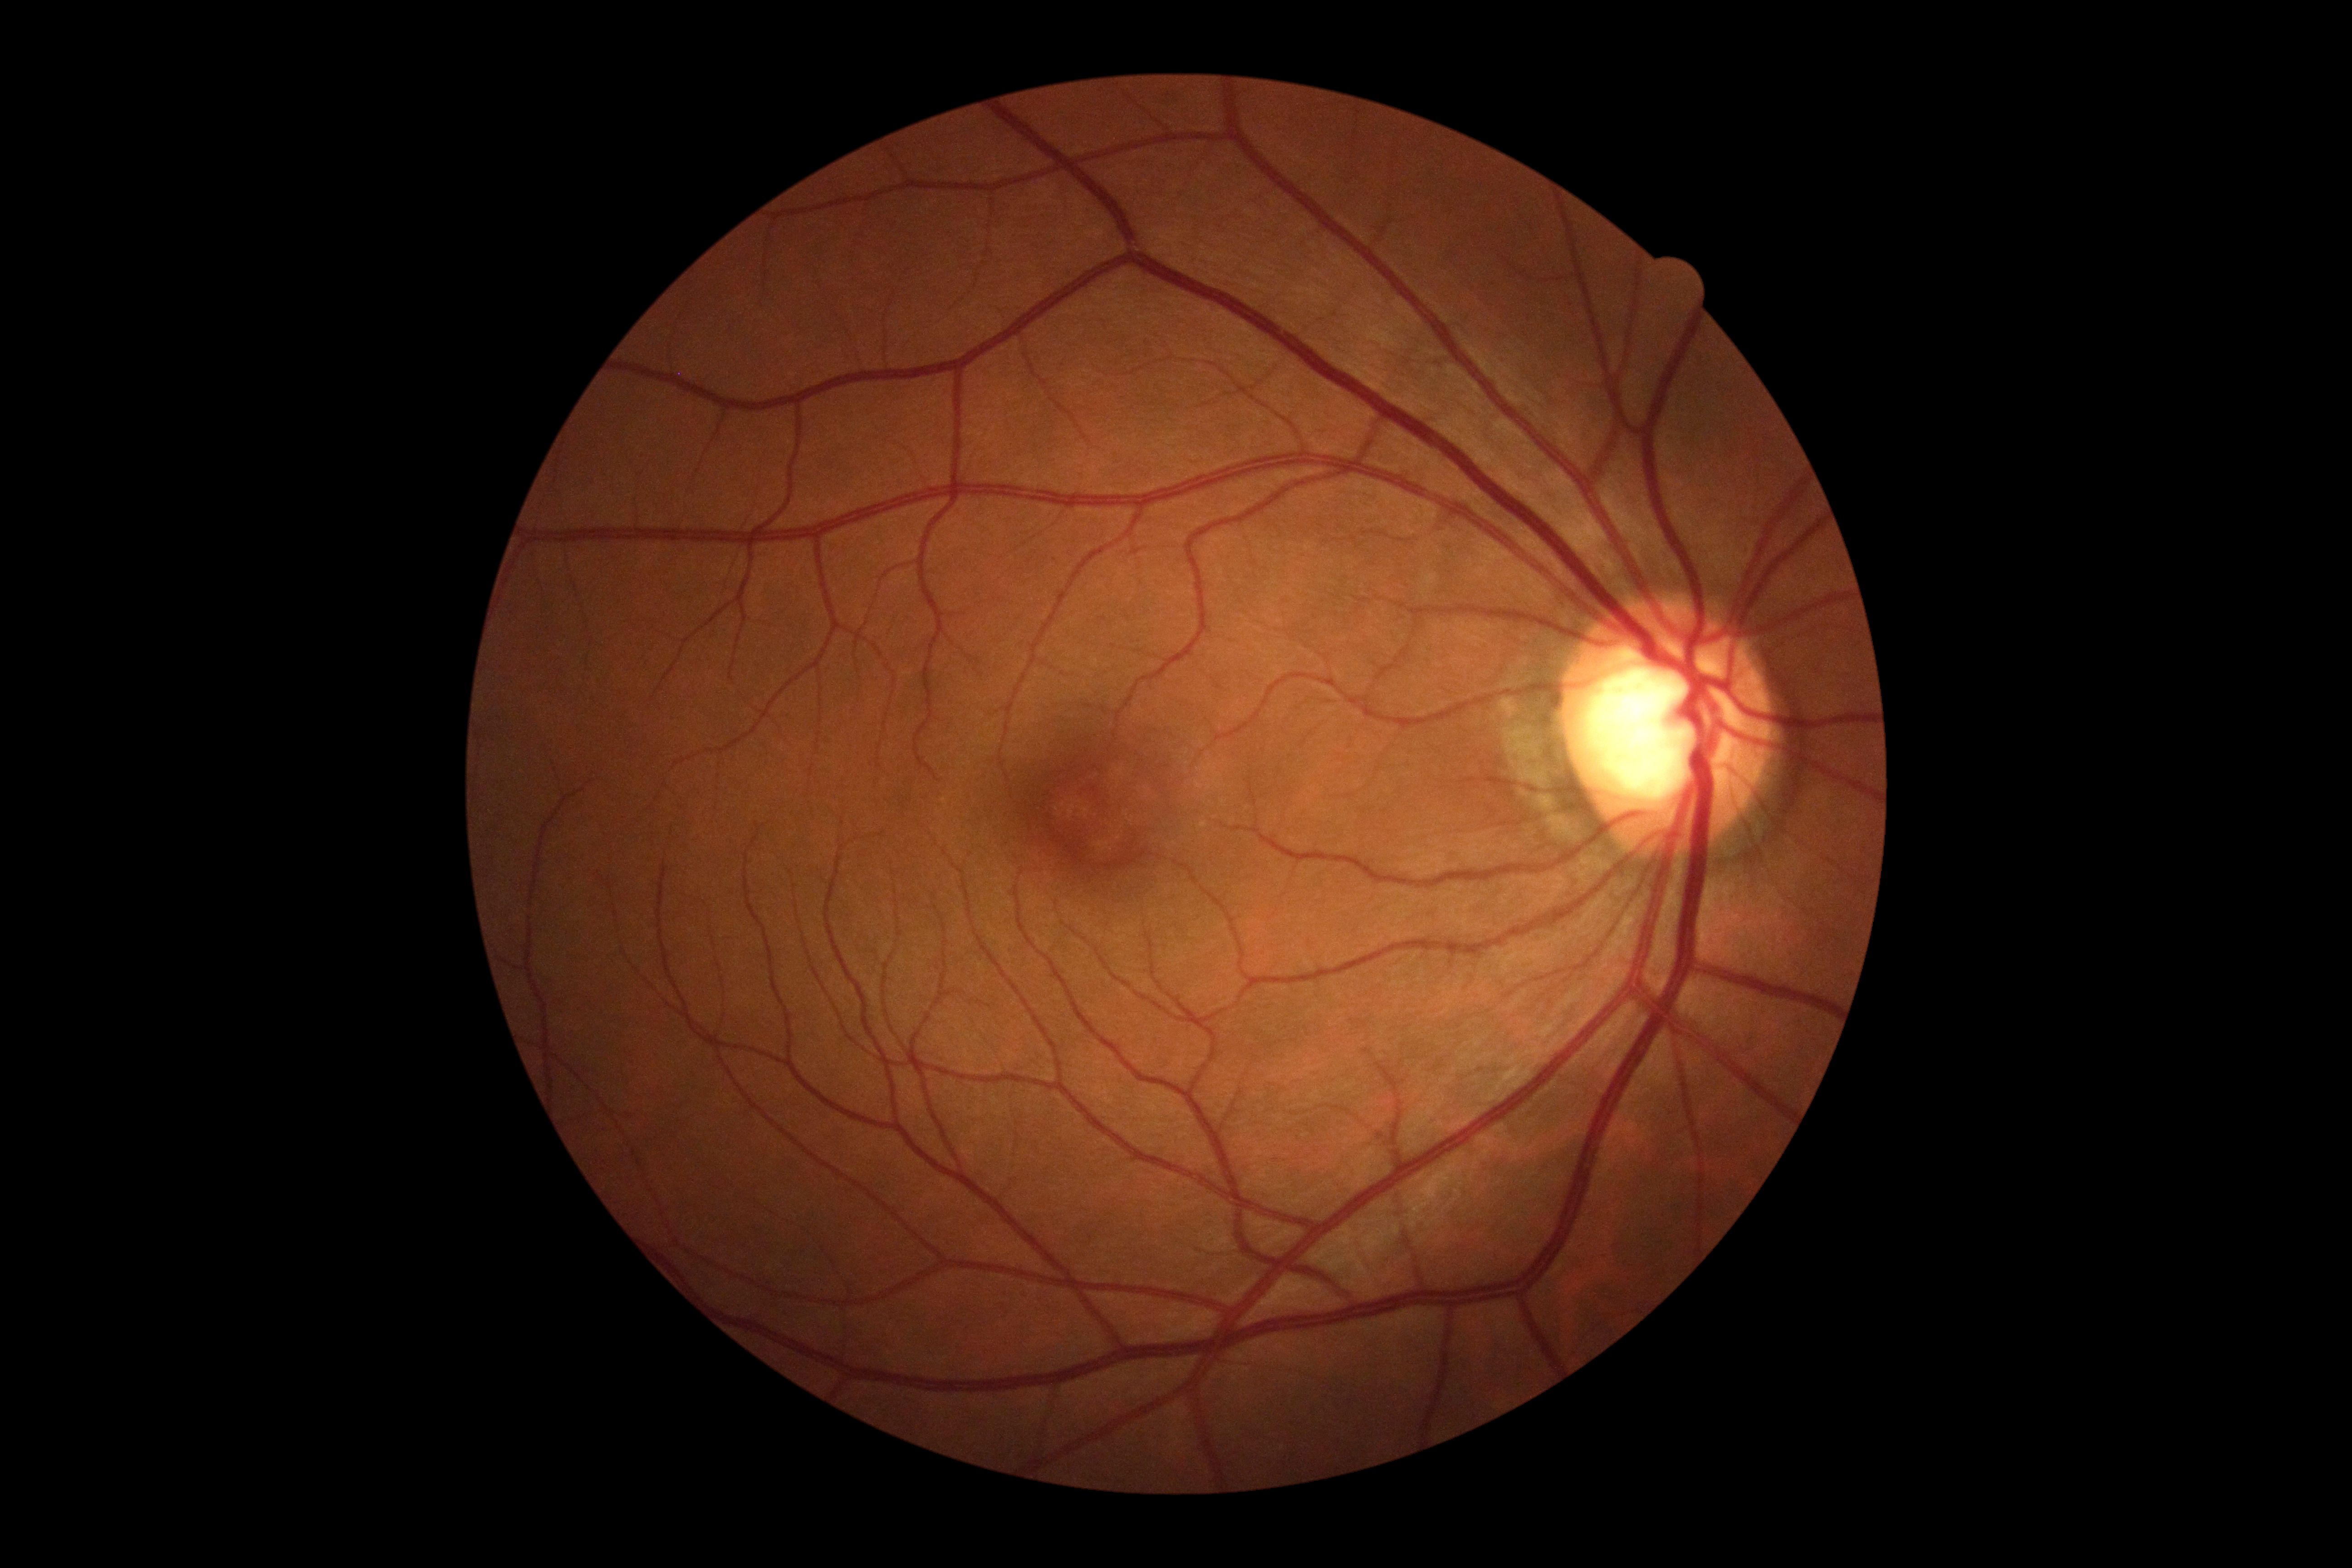 DR severity: grade 0 (no apparent retinopathy).